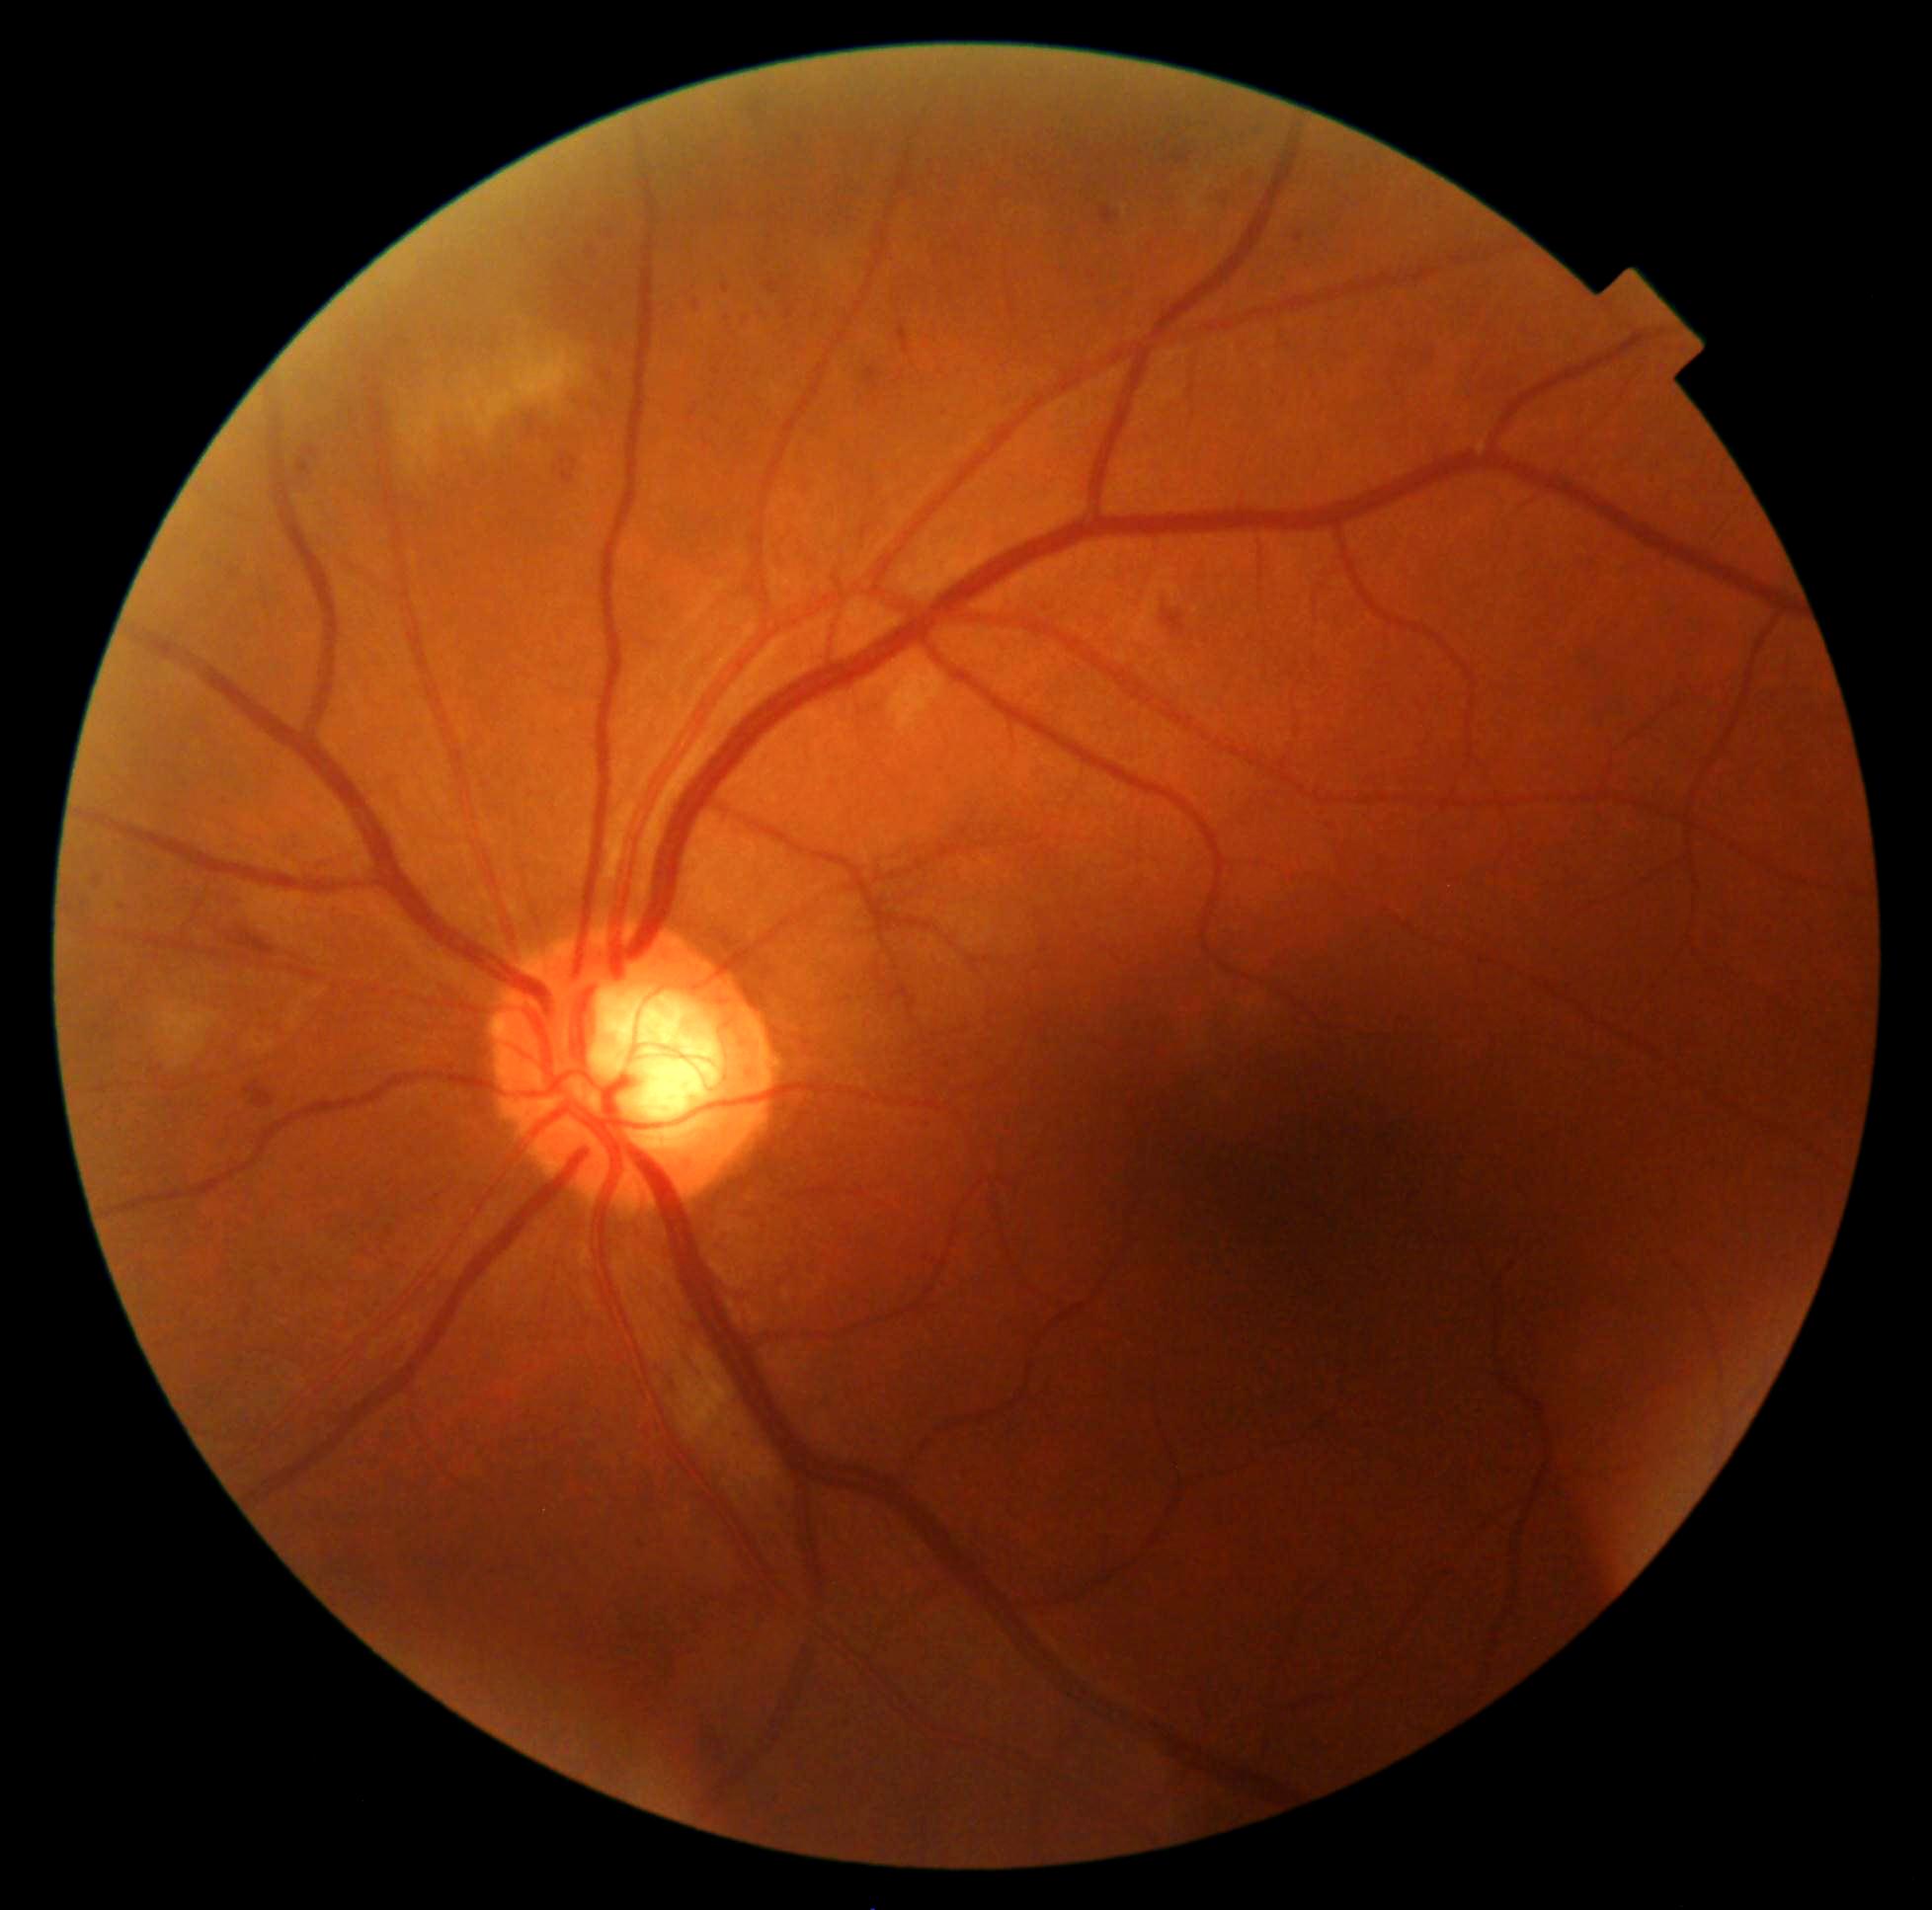 Findings:
* DR: grade 2 (moderate NPDR)
* DR class: non-proliferative diabetic retinopathy